848x848px · graded on the modified Davis scale:
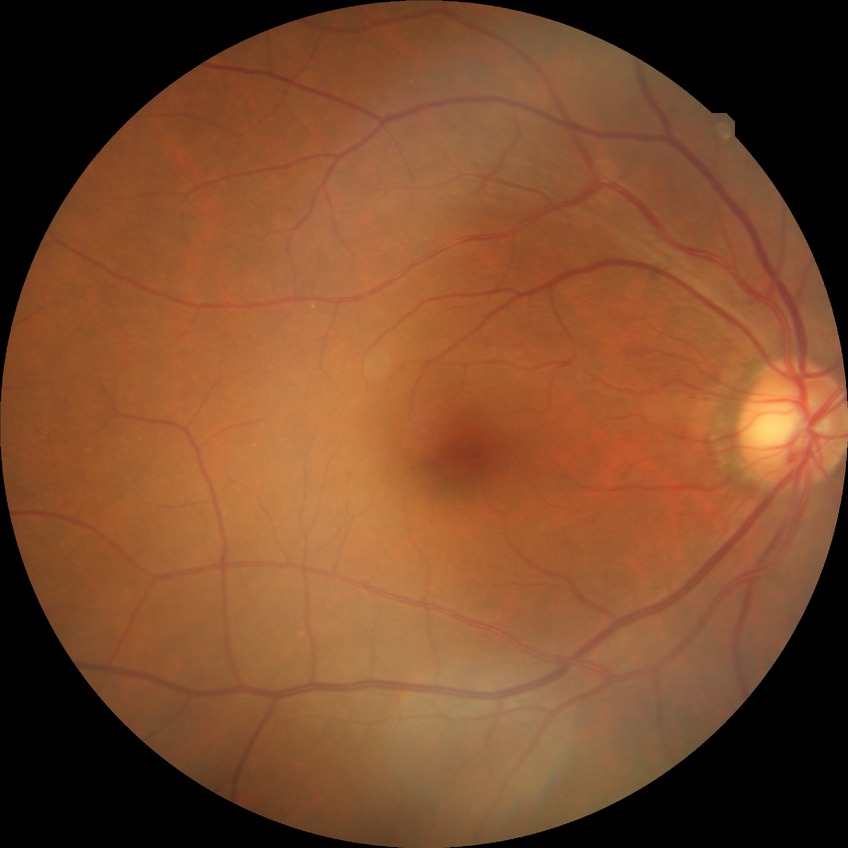
diabetic retinopathy (DR): no diabetic retinopathy (NDR).